Without pupil dilation:
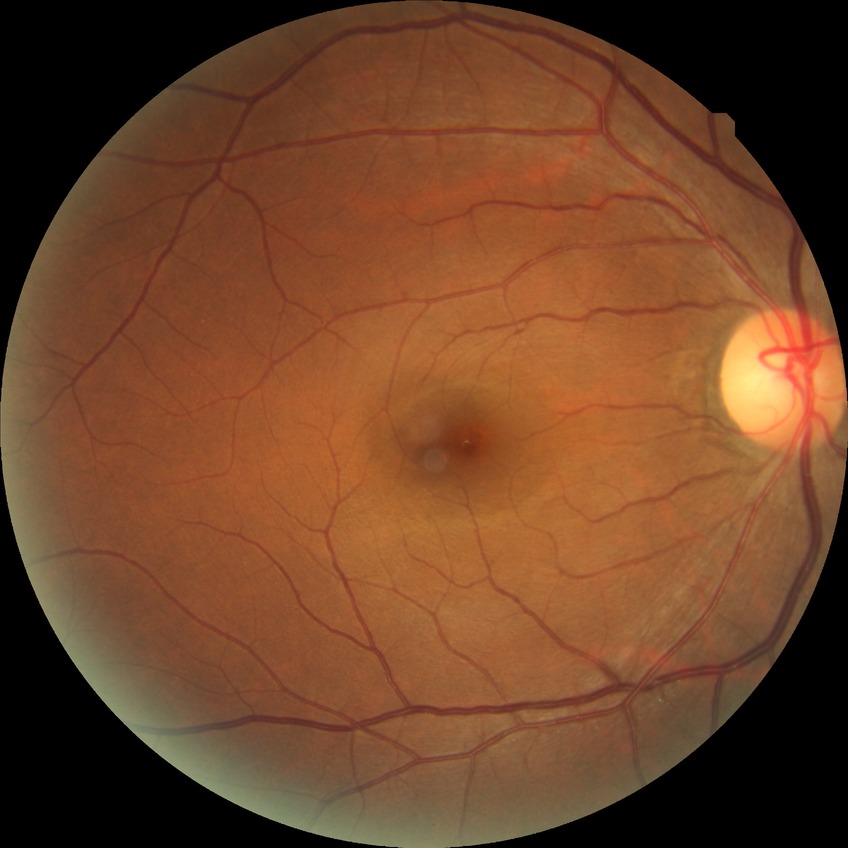

Retinopathy stage: no diabetic retinopathy.